Wide-field fundus image from infant ROP screening:
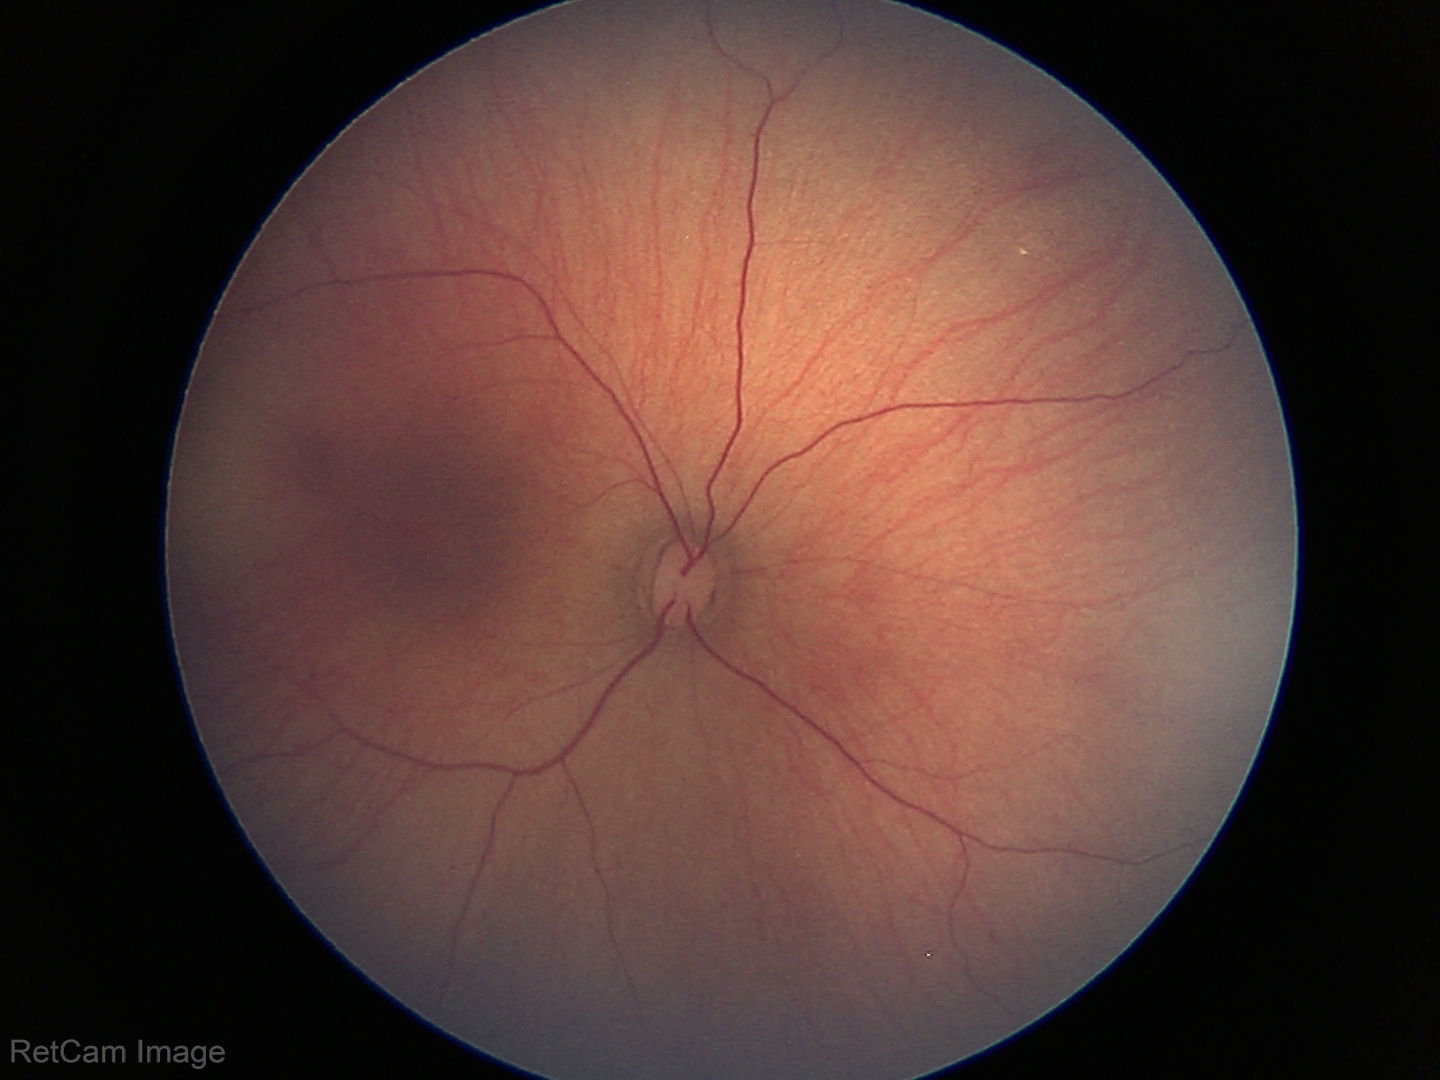 Physiological retinal appearance for postconceptual age.